Wide-field fundus photograph of an infant; 640x480 — 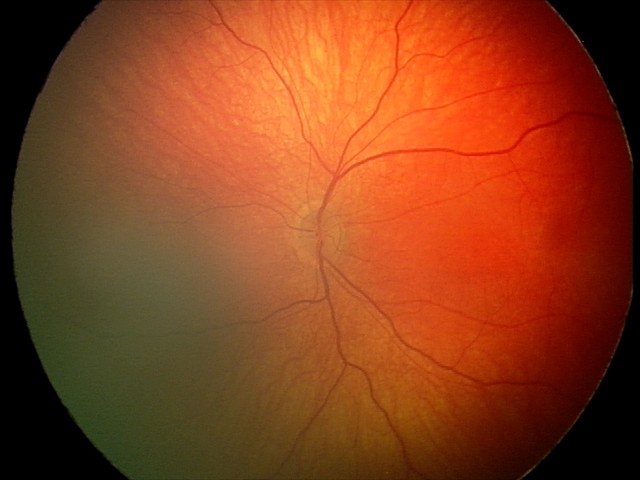
Assessment: retinal hemorrhages.